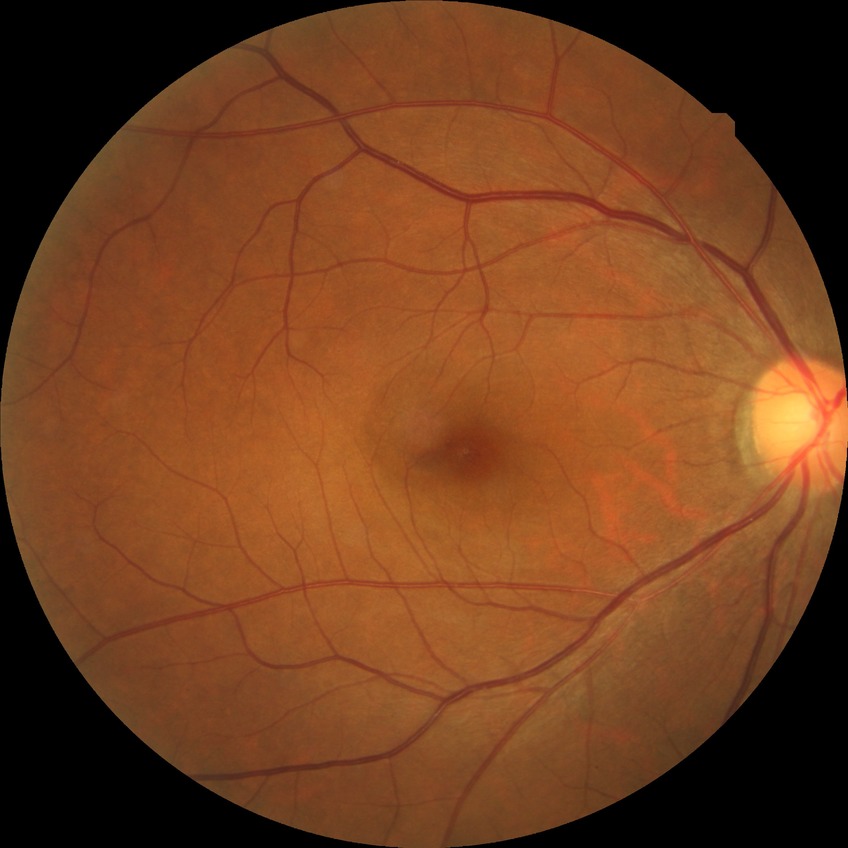

Diabetic retinopathy (DR) is NDR (no diabetic retinopathy).